Wide-field fundus image from infant ROP screening · 130° field of view (Clarity RetCam 3).
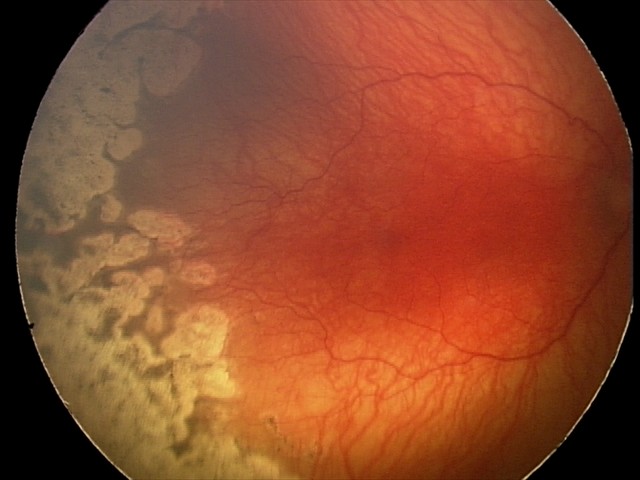

Plus disease was diagnosed.
Examination diagnosed as aggressive retinopathy of prematurity.